Color fundus image: 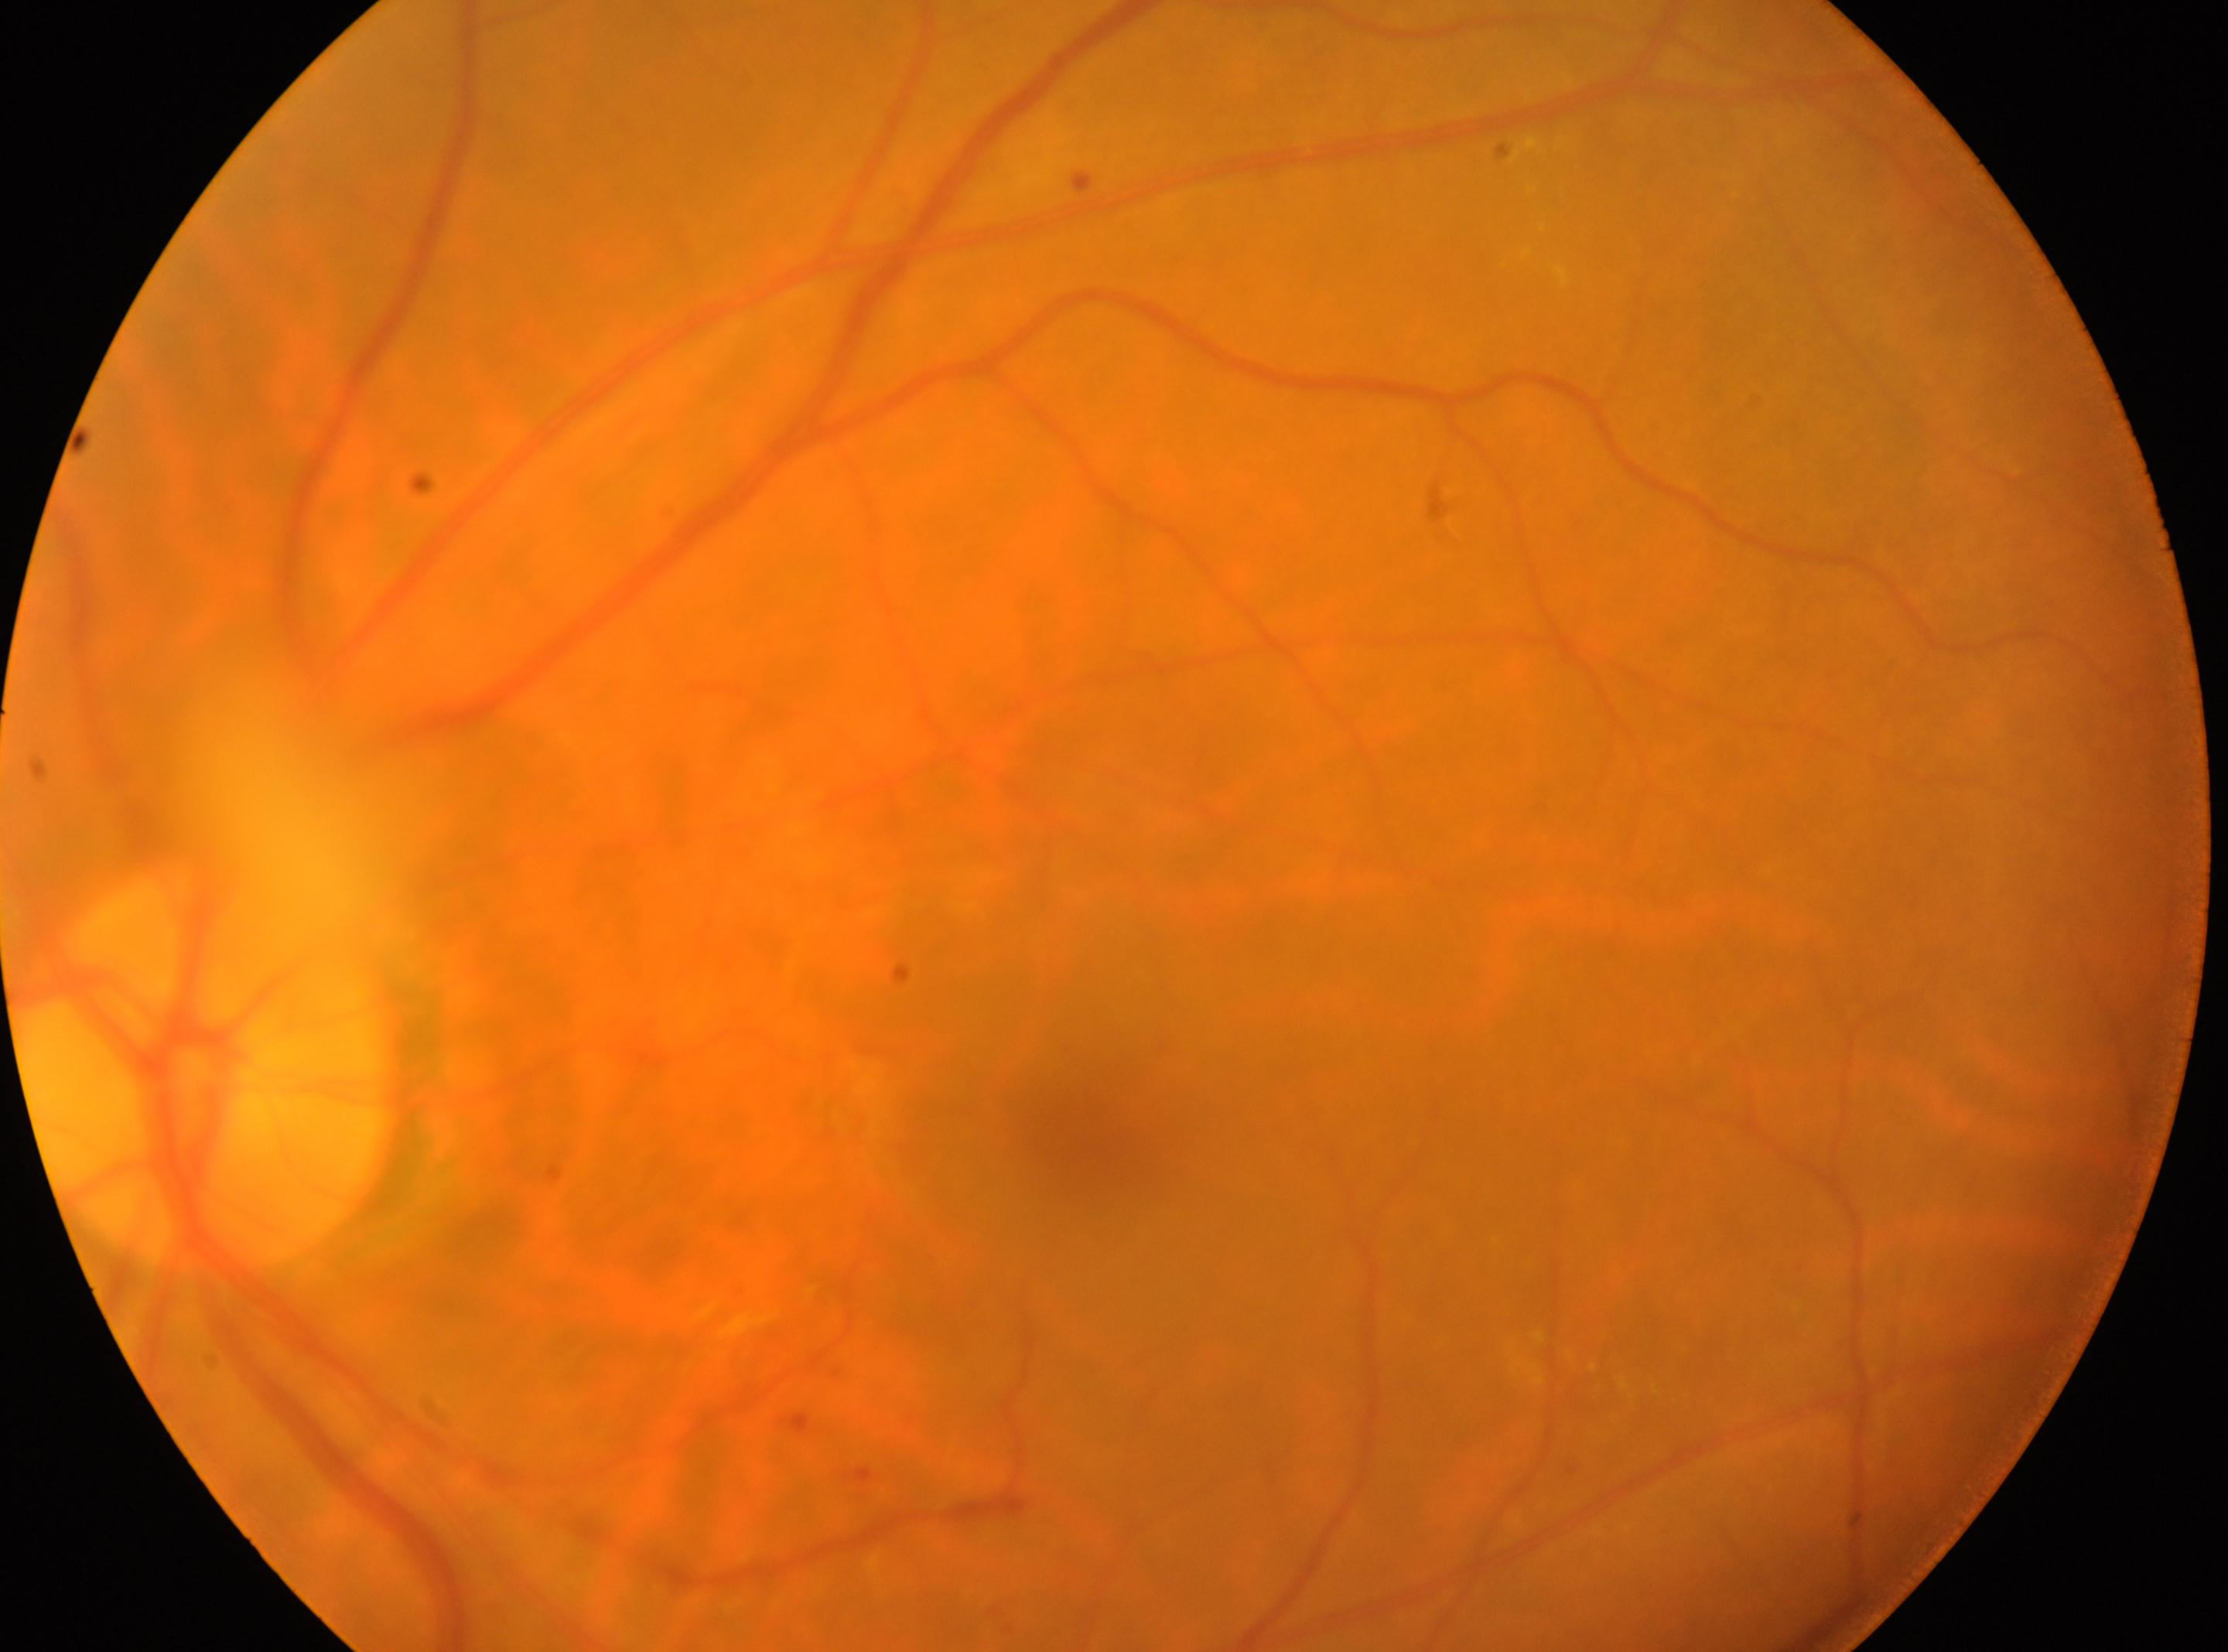 Optic disc located at (203, 1063). DR grade is moderate non-proliferative diabetic retinopathy (2). The fovea centralis is at (1089, 1146). Imaged eye: oculus sinister.